Infant wide-field retinal image; image size 1240x1240.
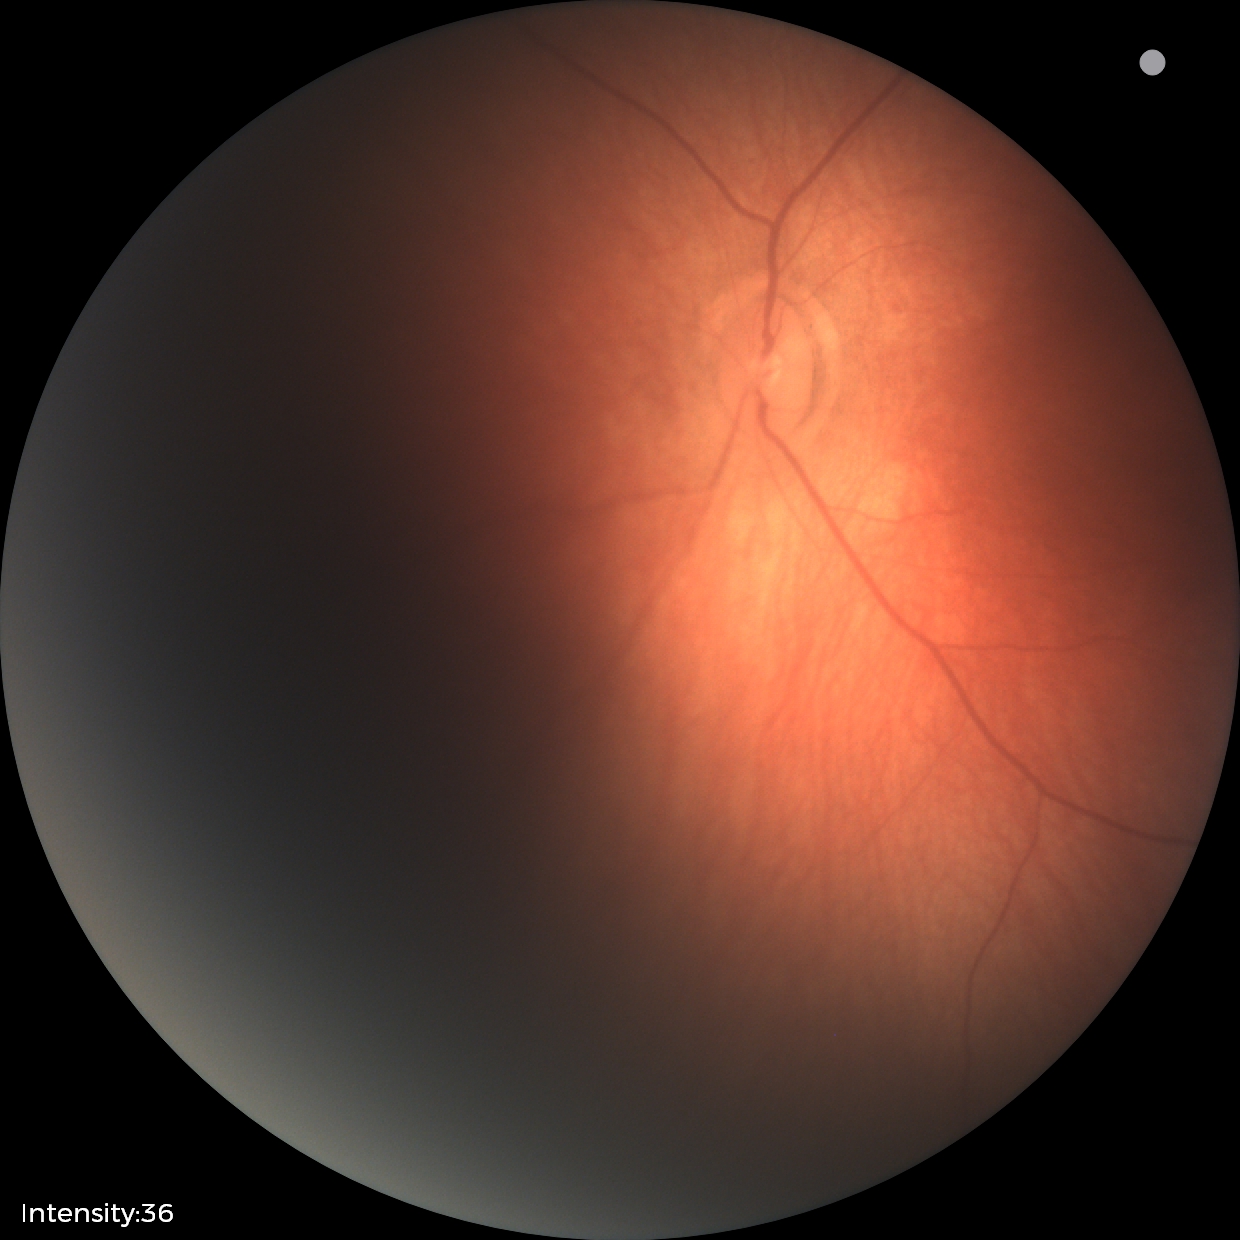

No retinal pathology identified on screening.